Color fundus image, 512 x 512 pixels: 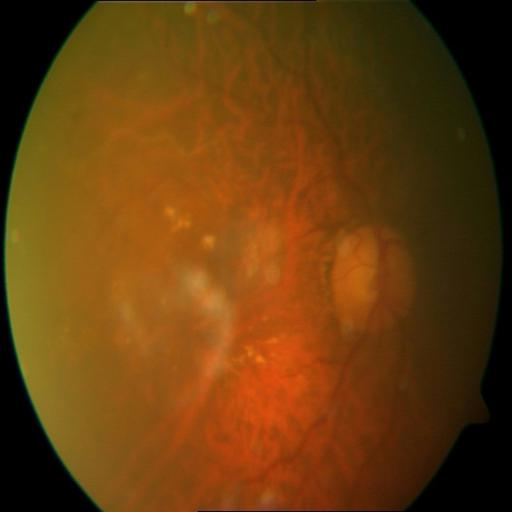

Diagnoses: CWS (cotton wool spots).